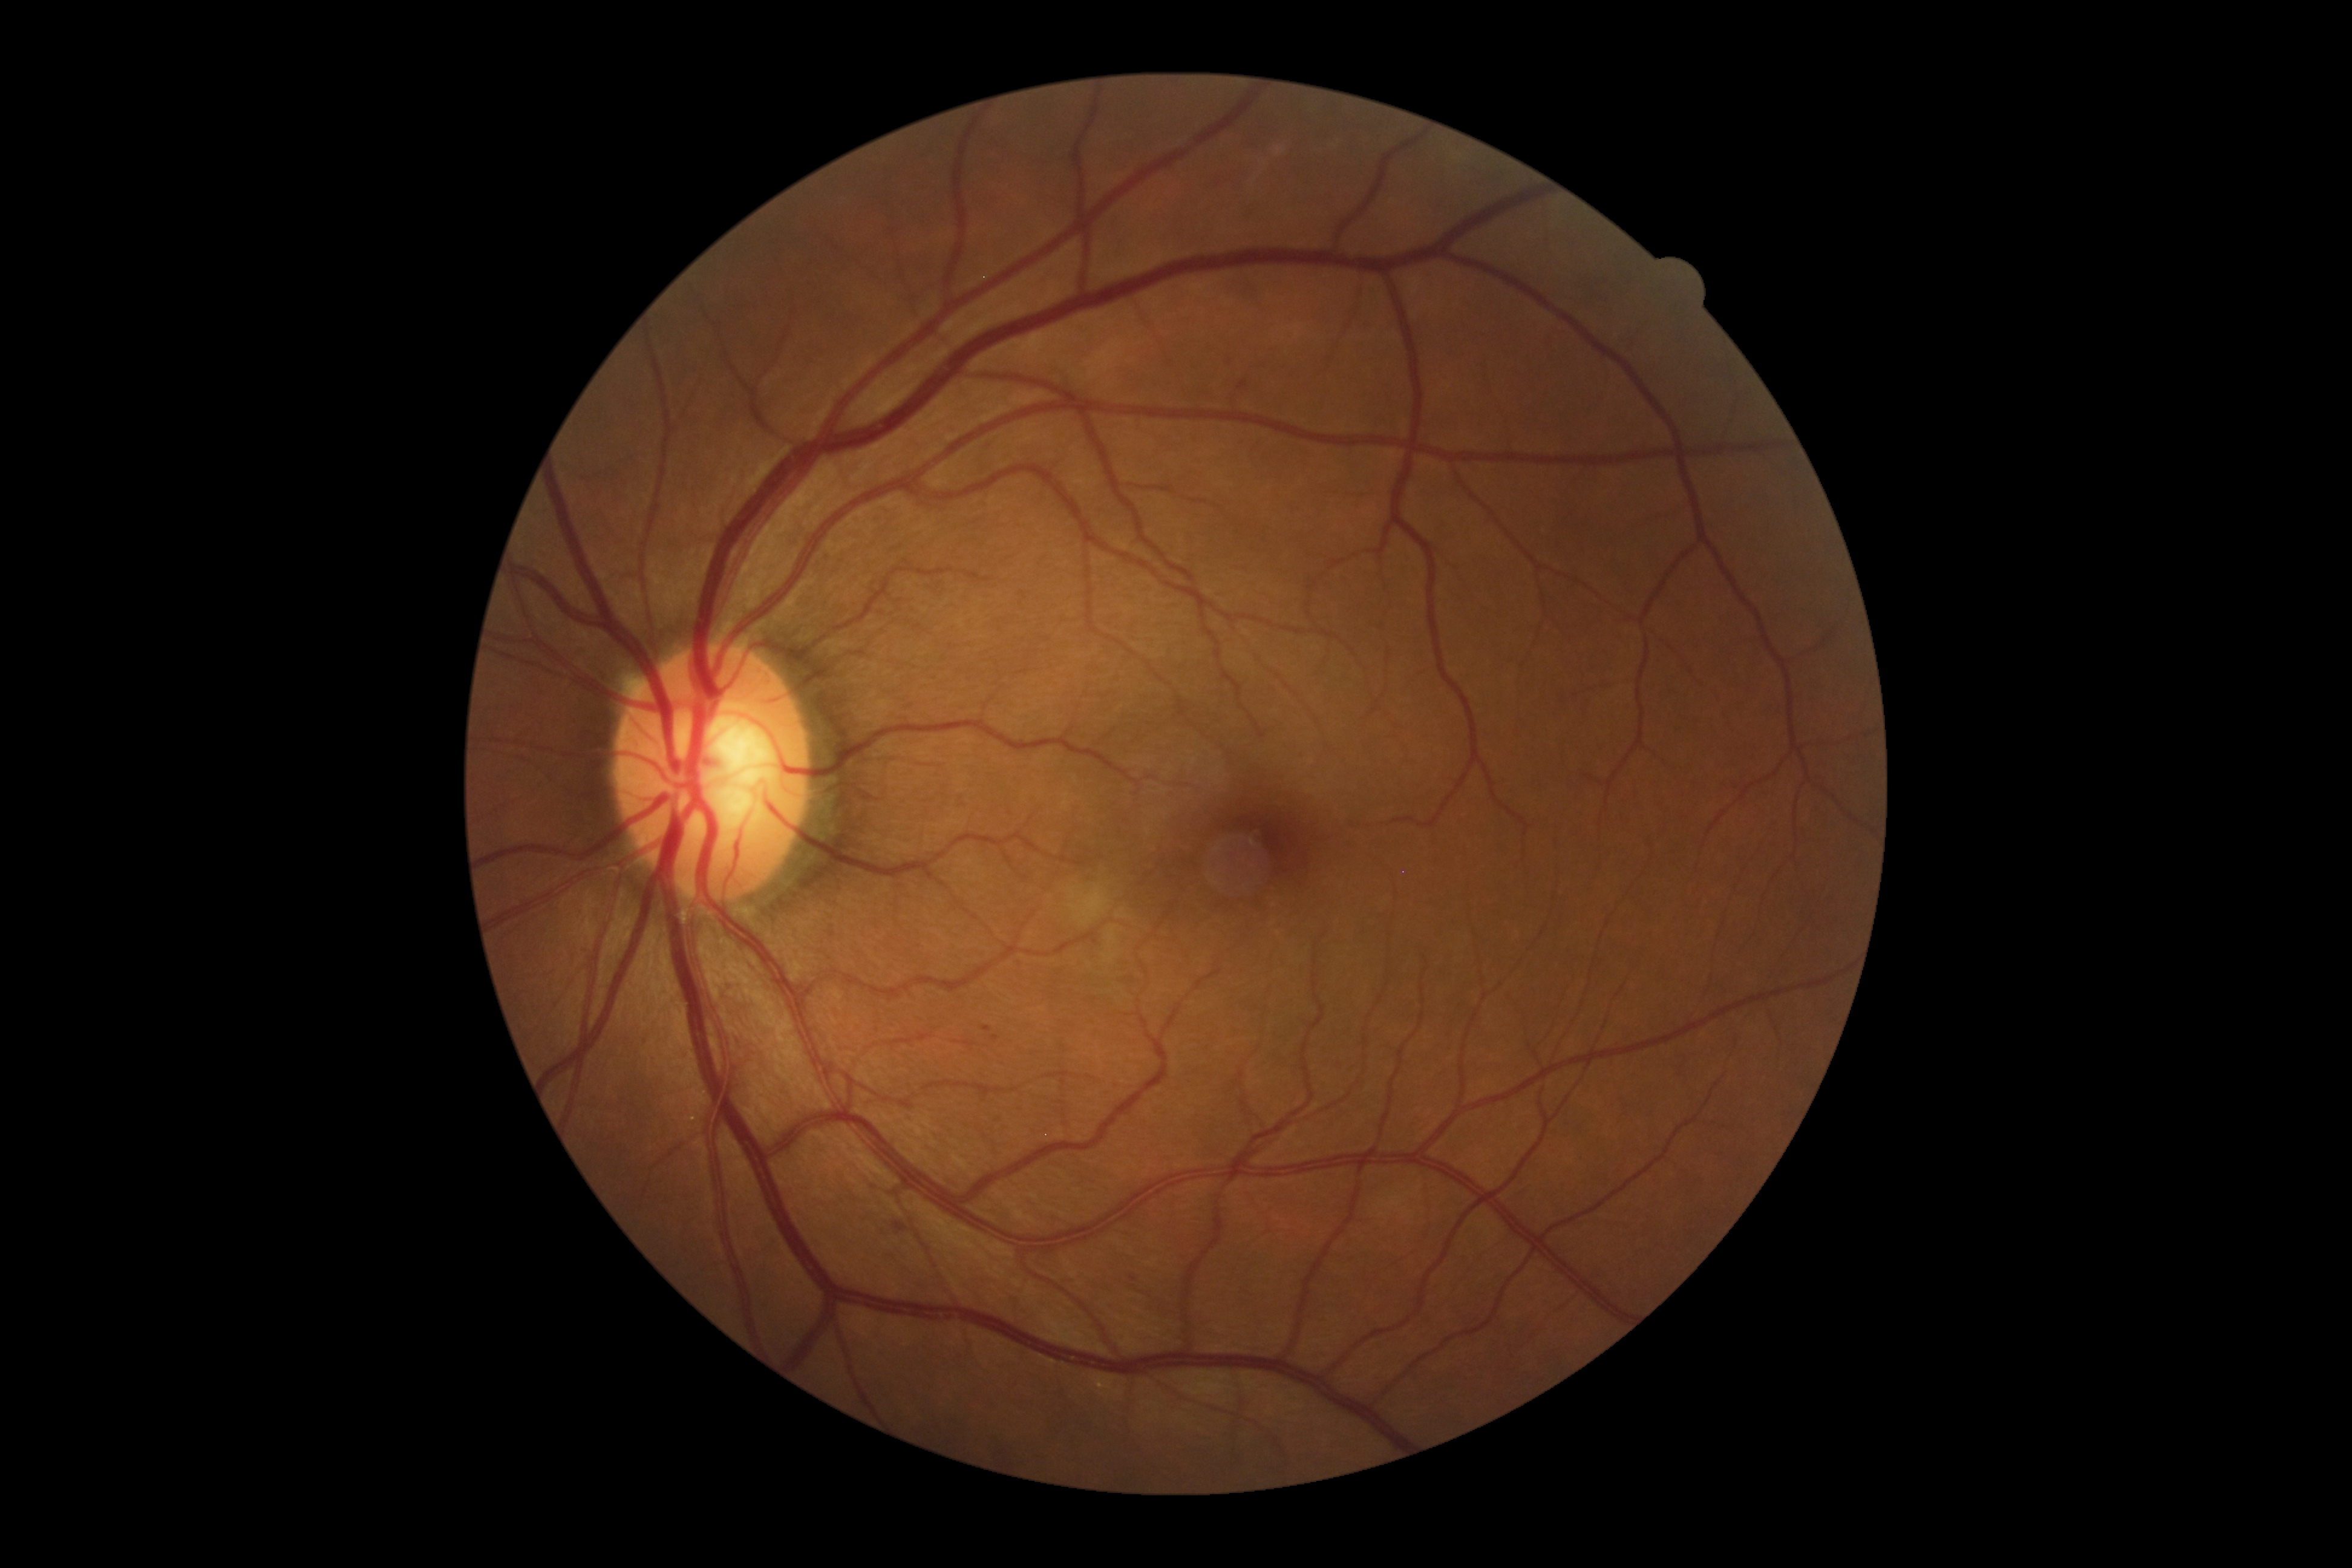
DR grade is 2 (moderate NPDR).